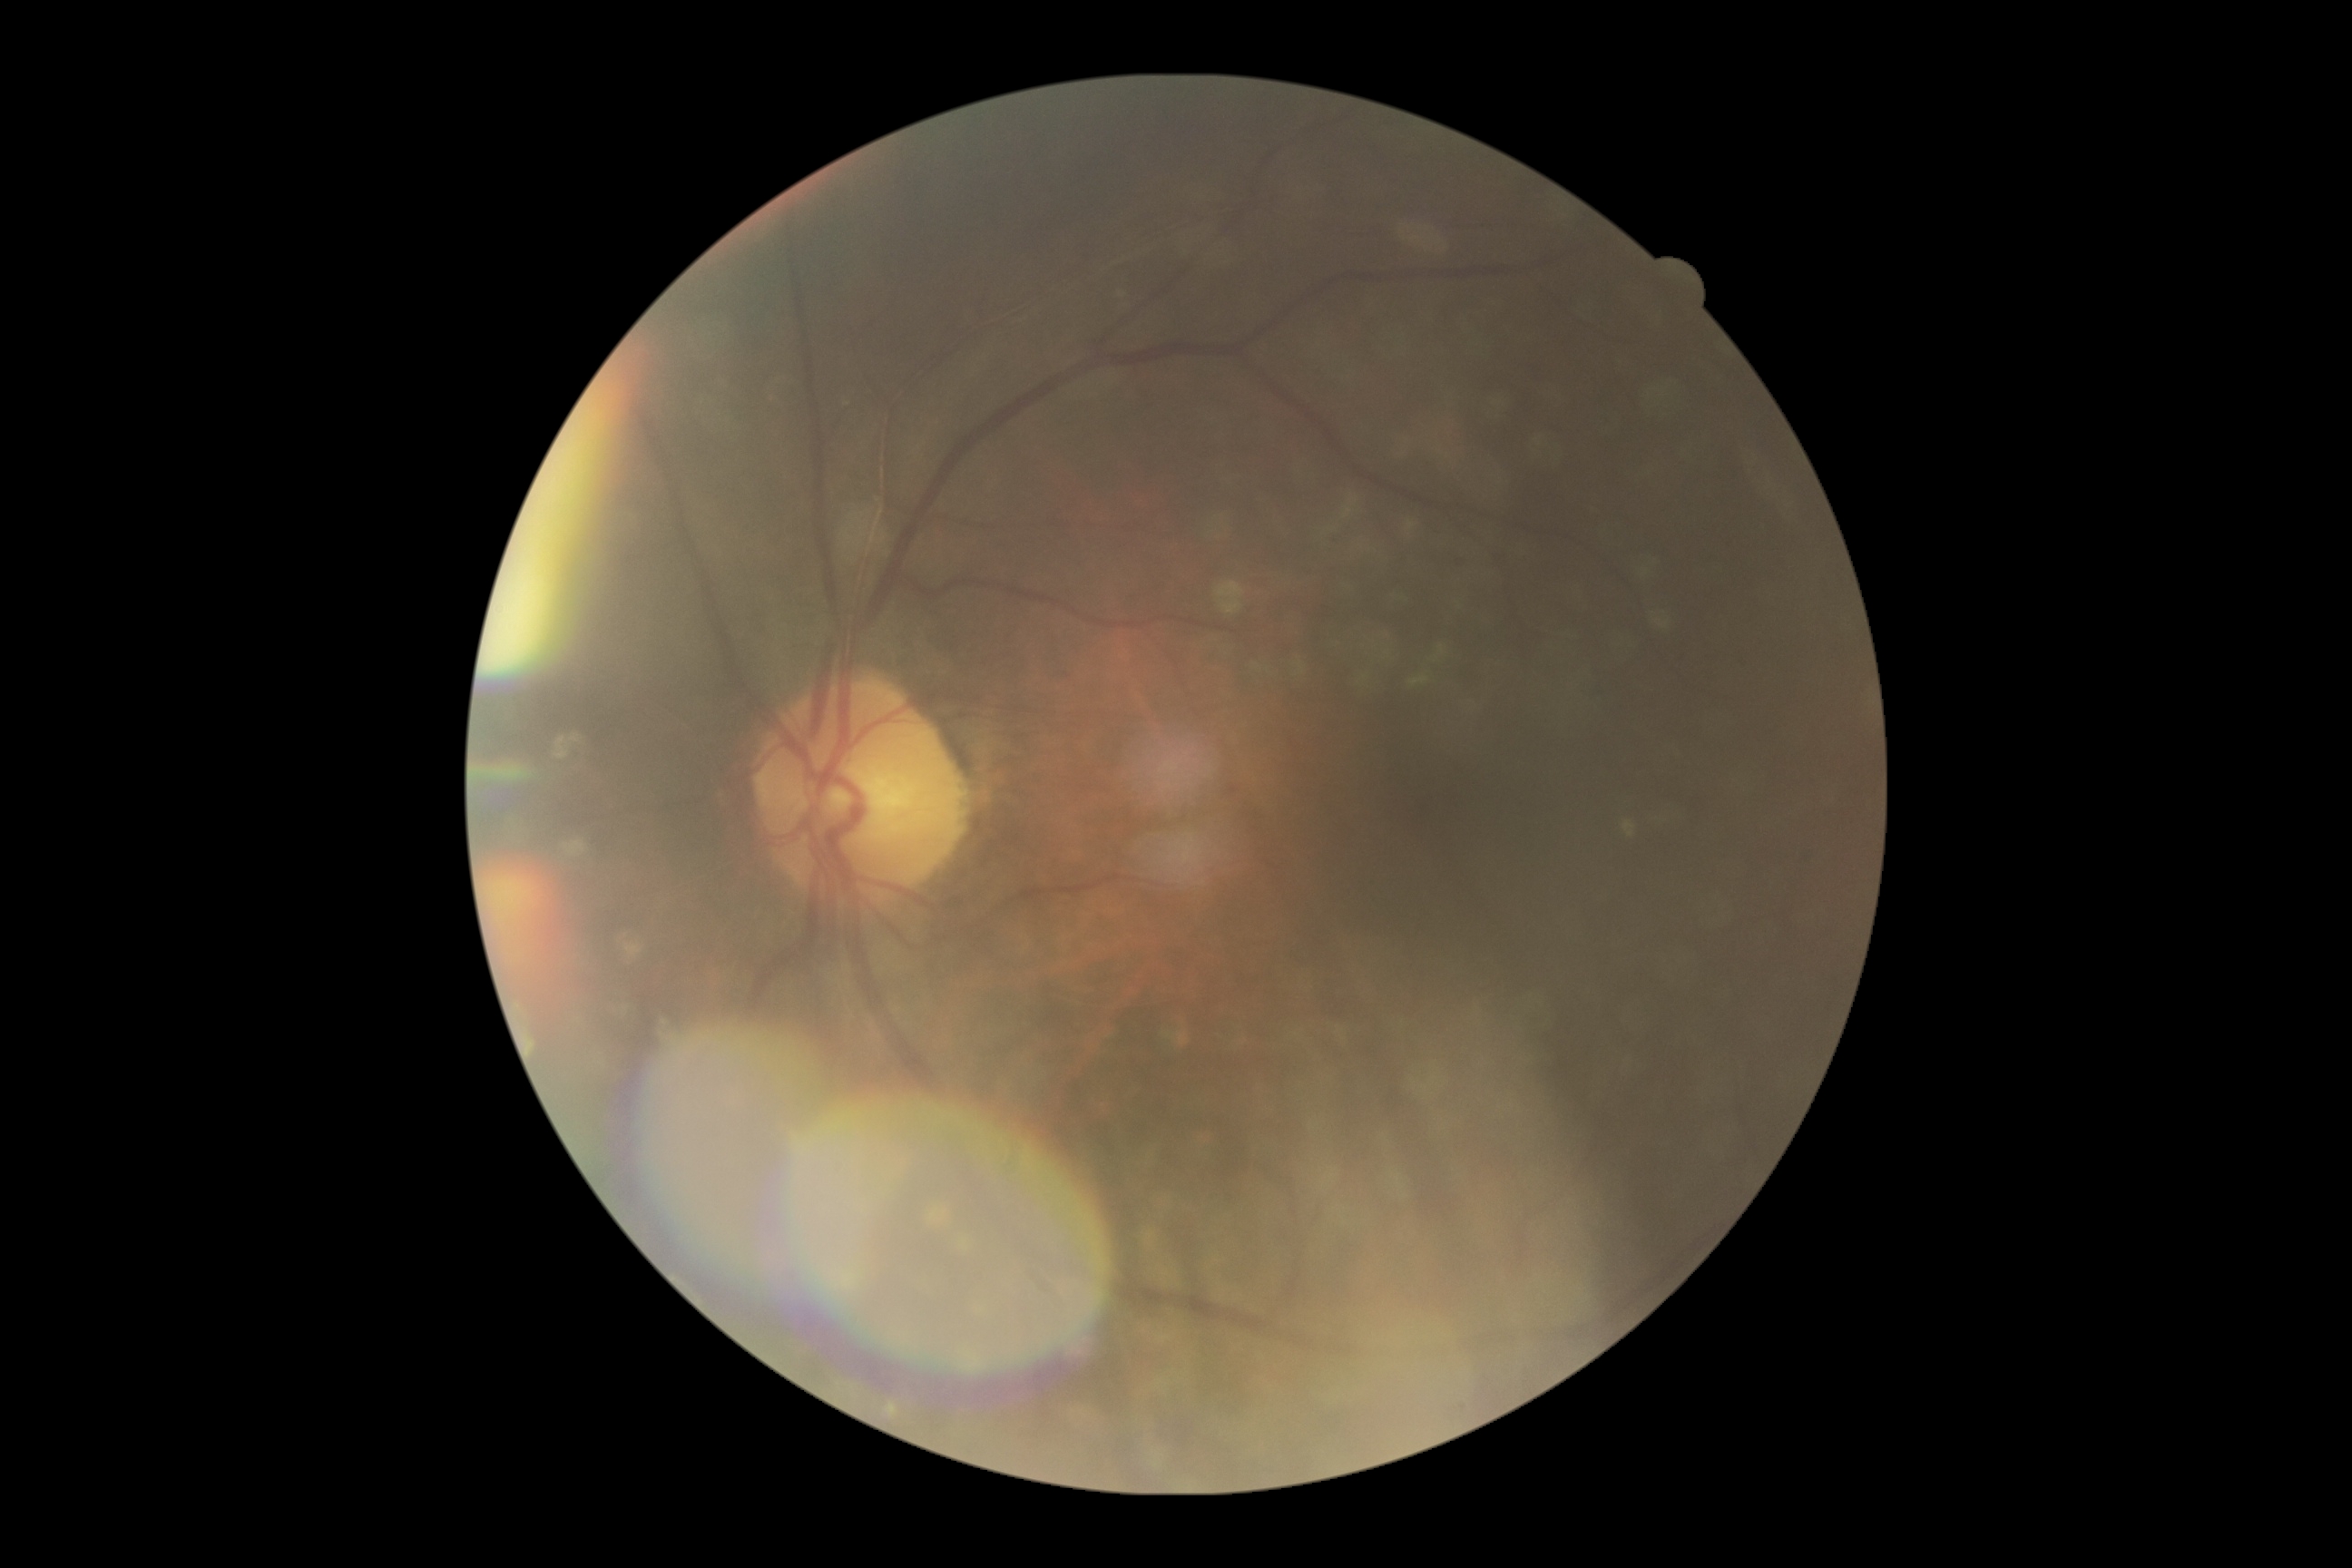 DR stage is grade 1 (mild NPDR).